Posterior pole photograph. NIDEK AFC-230. Nonmydriatic: 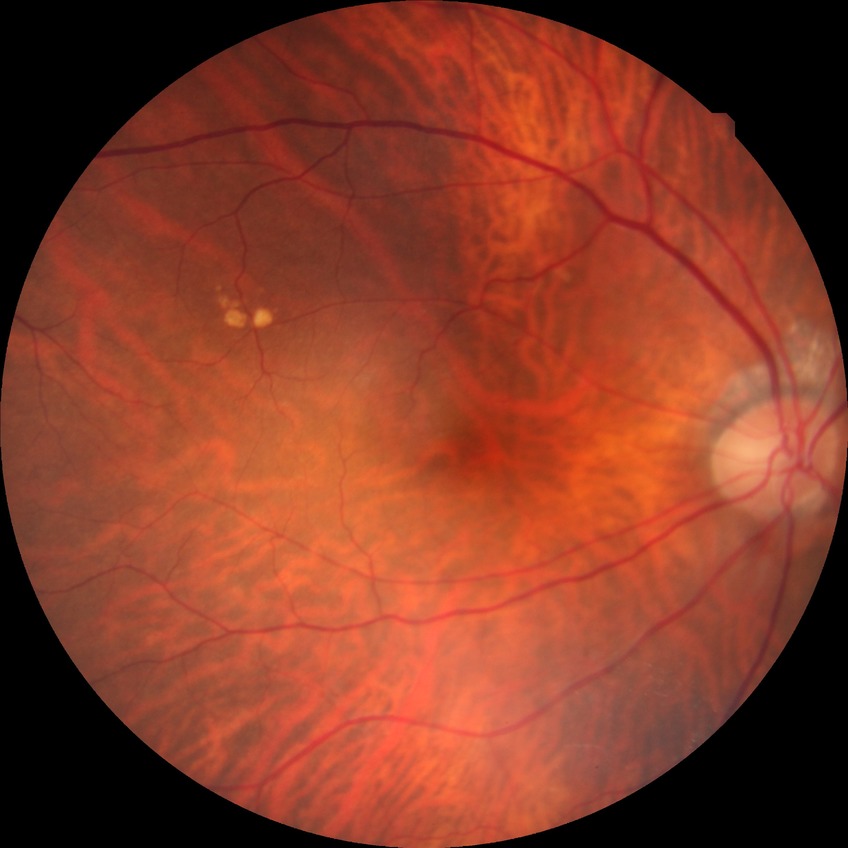

Diabetic retinopathy (DR) is no diabetic retinopathy (NDR).